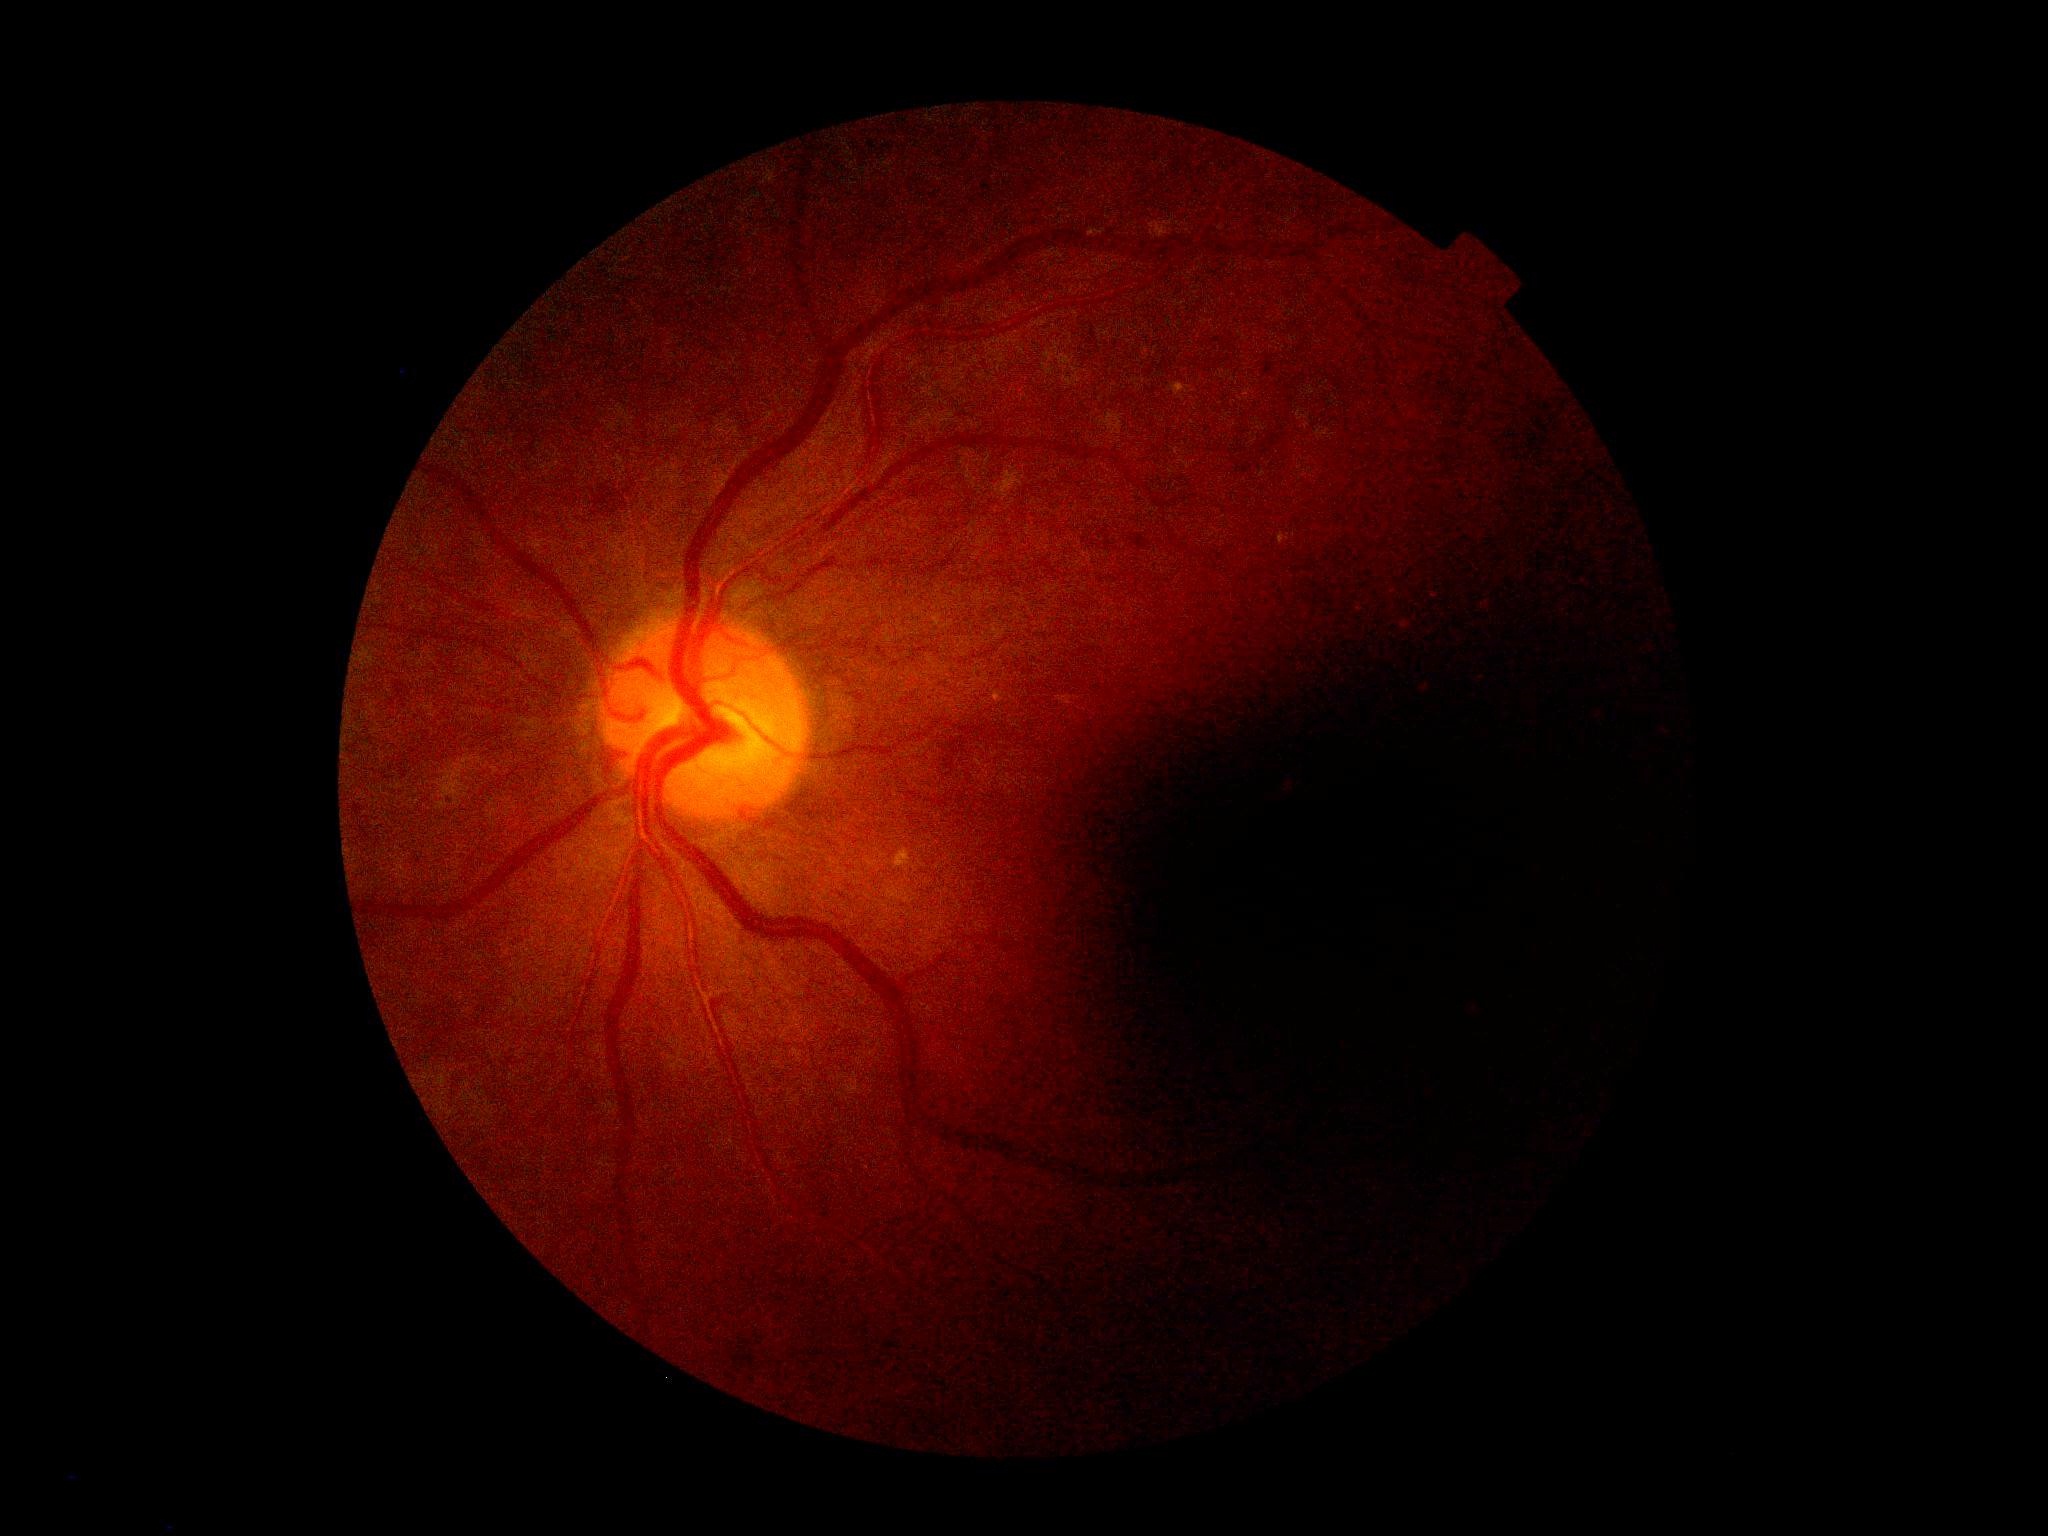 DR stage = moderate non-proliferative diabetic retinopathy (grade 2); DR class = non-proliferative diabetic retinopathy.